2346x1568px
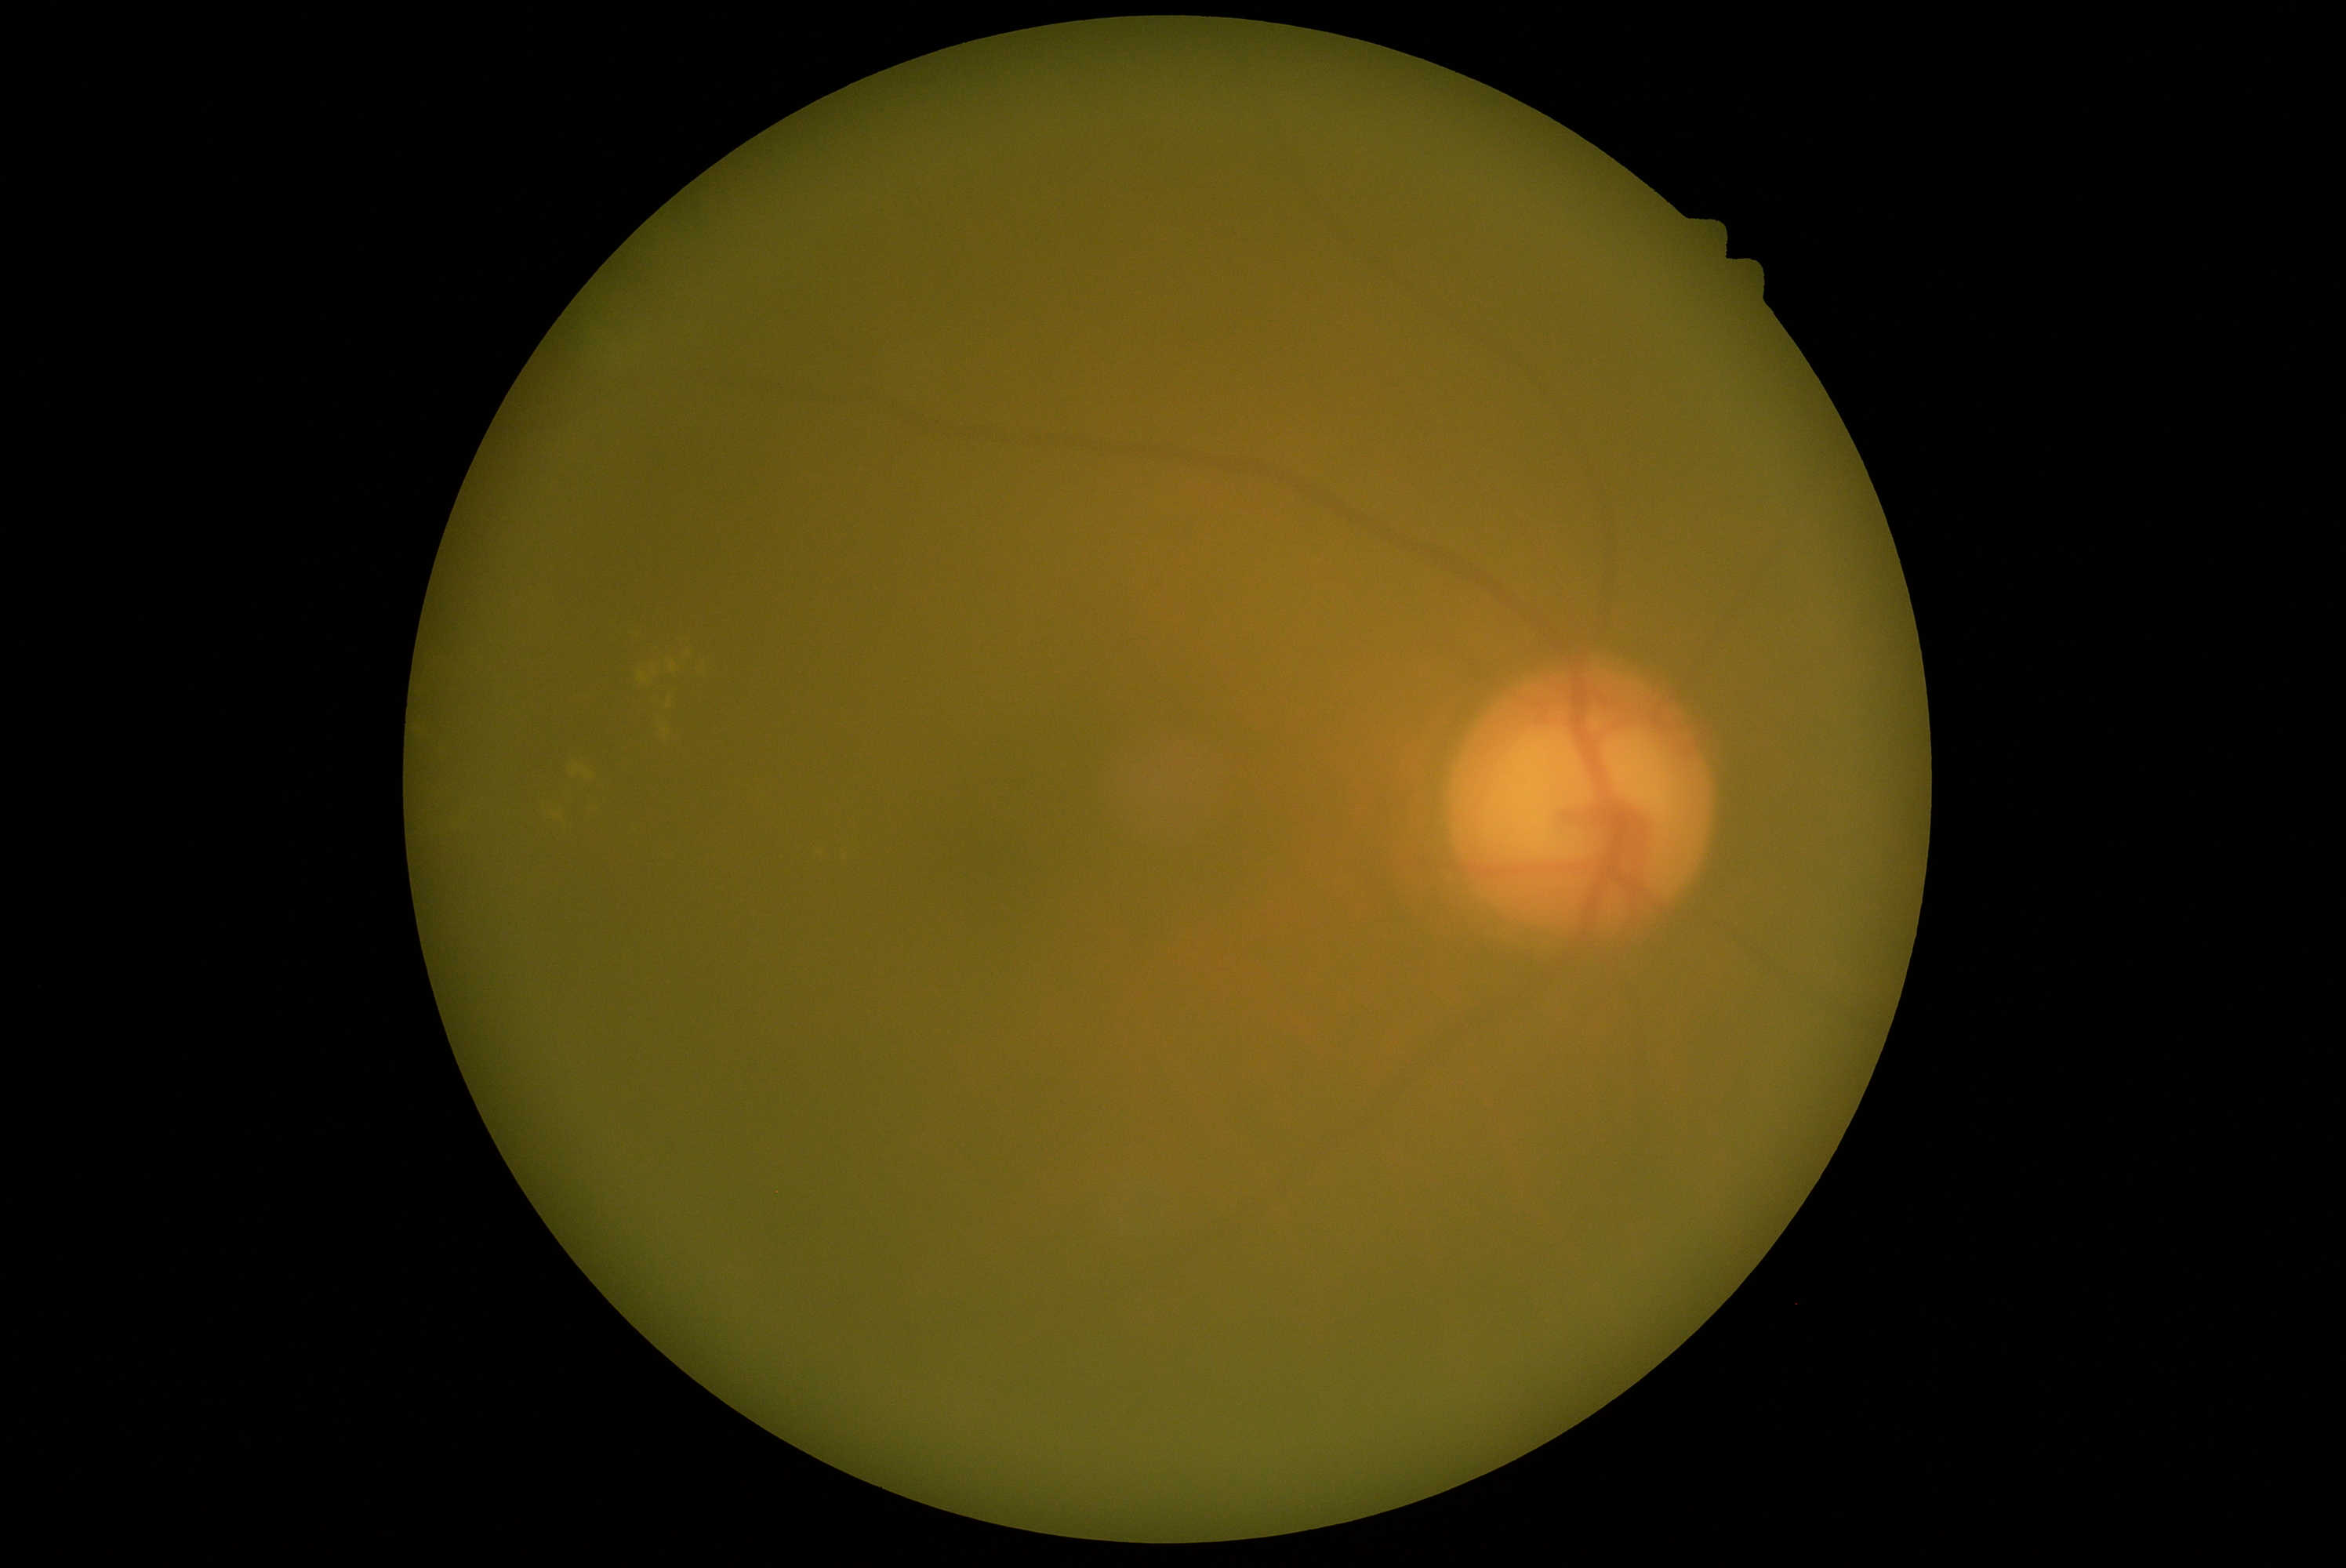
dr_category: non-proliferative diabetic retinopathy
dr_grade: moderate NPDR (grade 2)